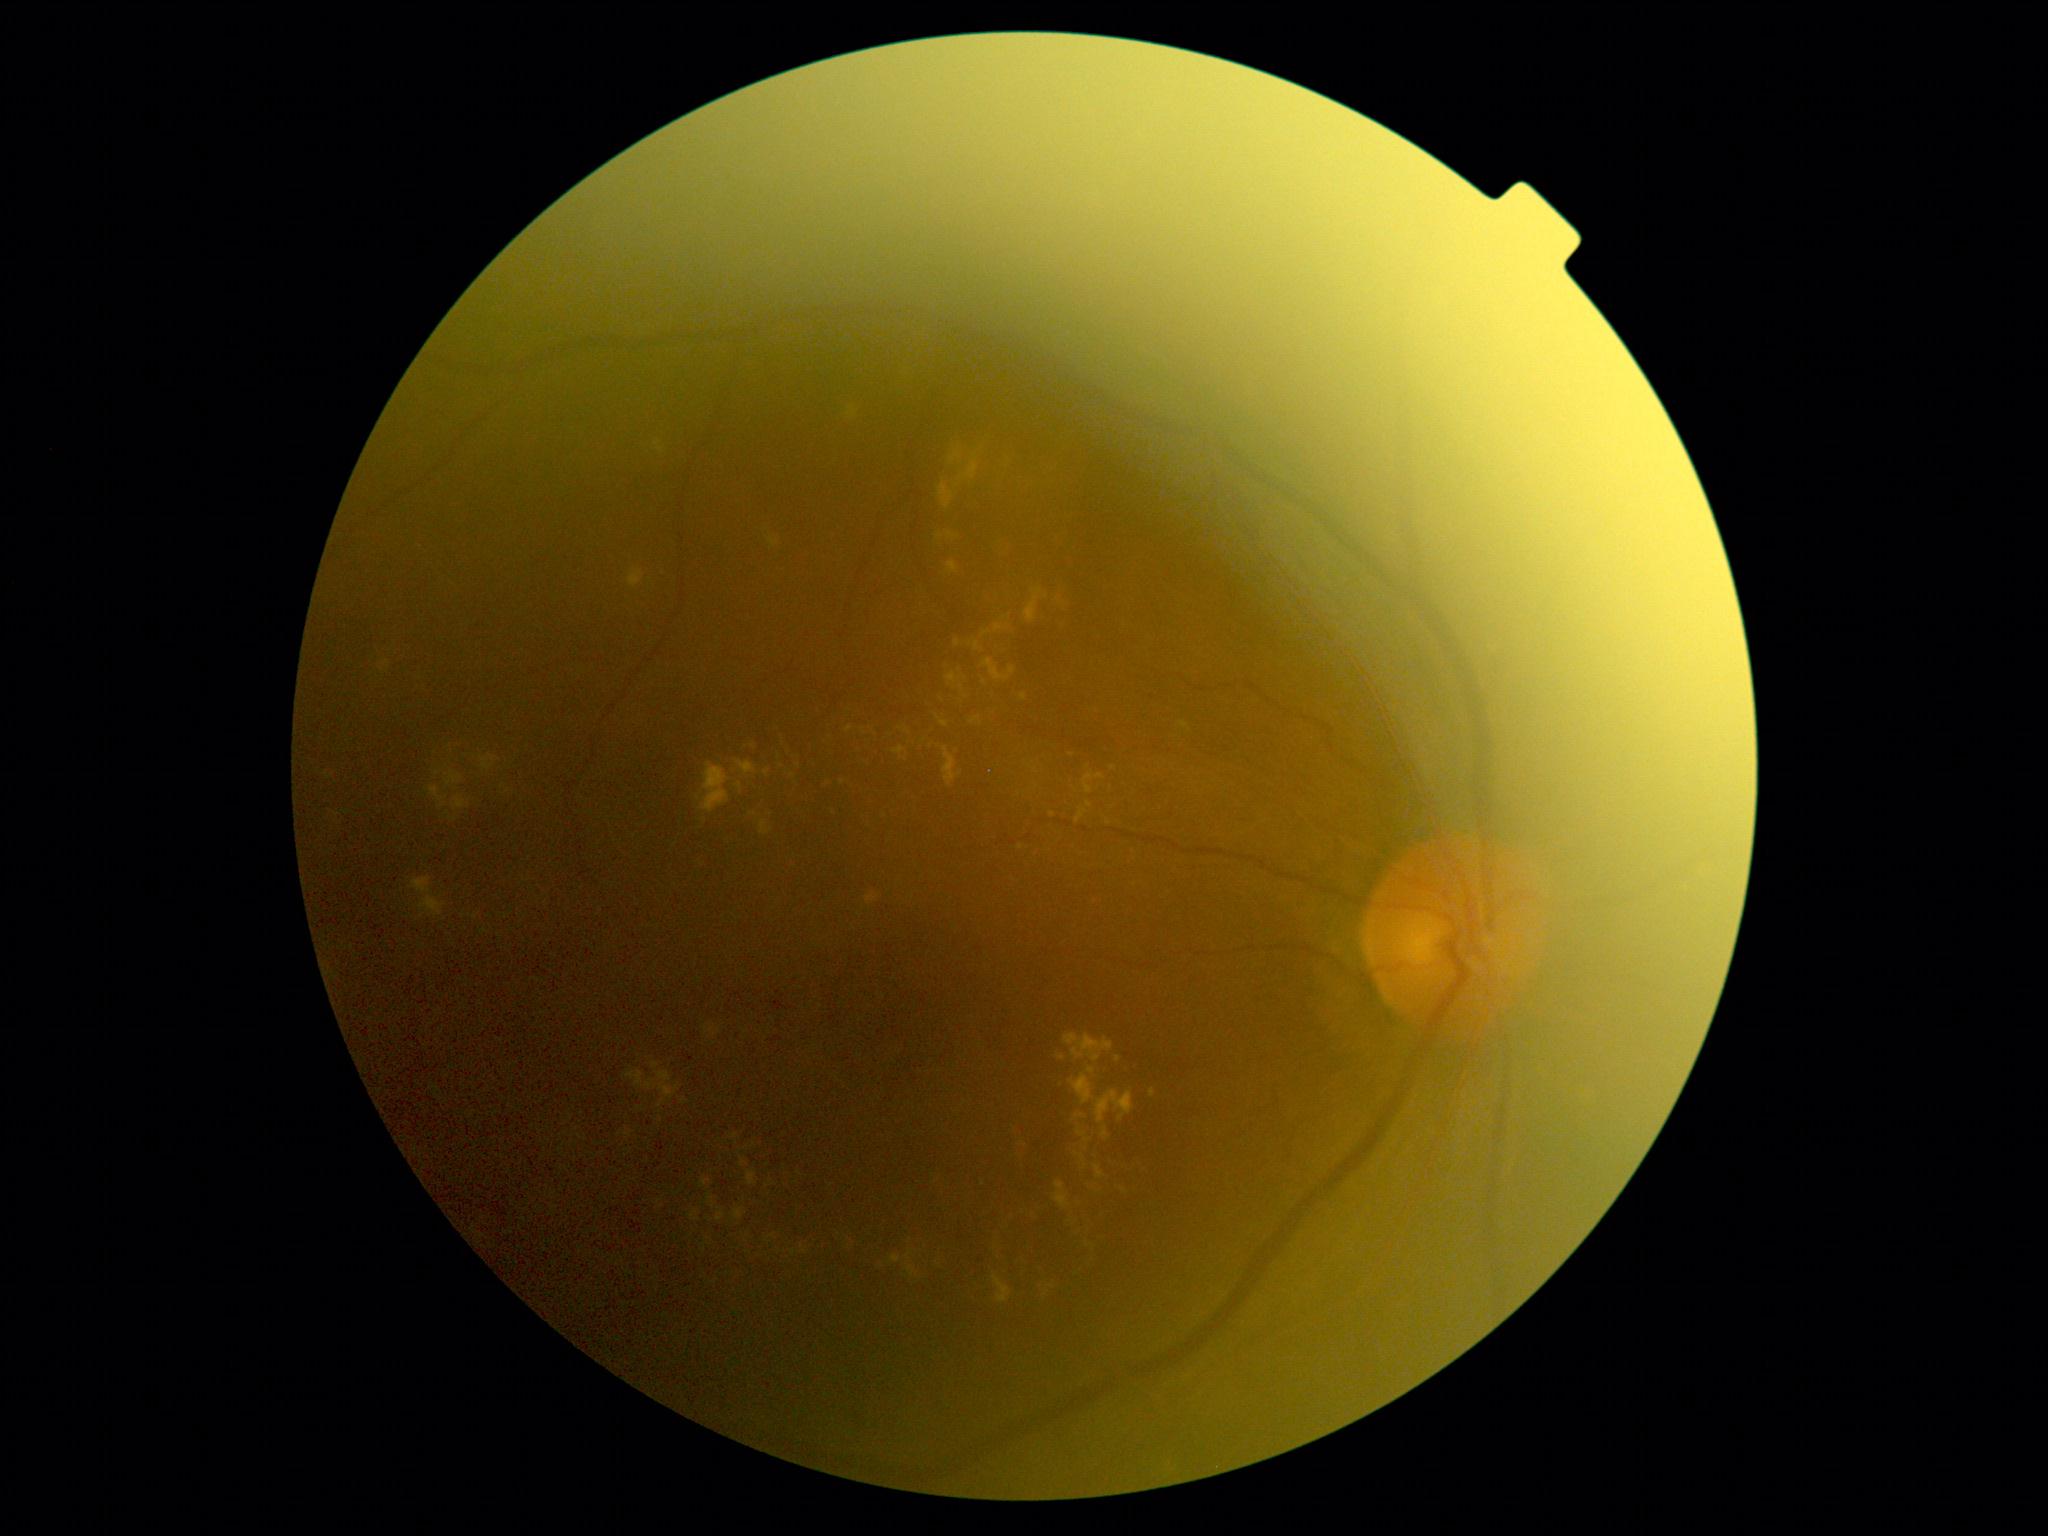 DR stage: 2/4 — more than just microaneurysms but less than severe NPDR; non-proliferative diabetic retinopathy. EXs (partial list) at x1=625, y1=1071, x2=681, y2=1100 | x1=1094, y1=1165, x2=1105, y2=1180 | x1=651, y1=1062, x2=660, y2=1069 | x1=769, y1=538, x2=779, y2=549 | x1=949, y1=451, x2=962, y2=466 | x1=1069, y1=1067, x2=1097, y2=1105 | x1=445, y1=770, x2=463, y2=787 | x1=995, y1=624, x2=1005, y2=633 | x1=992, y1=1274, x2=1012, y2=1304 | x1=971, y1=717, x2=982, y2=724 | x1=1084, y1=773, x2=1105, y2=794 | x1=707, y1=1194, x2=716, y2=1208. Smaller EXs around <pt>1084,1167</pt> | <pt>966,697</pt> | <pt>962,688</pt> | <pt>1109,823</pt> | <pt>939,537</pt> | <pt>1061,1058</pt> | <pt>735,771</pt> | <pt>705,1249</pt>.